Image size 1920x1440 · color fundus image:
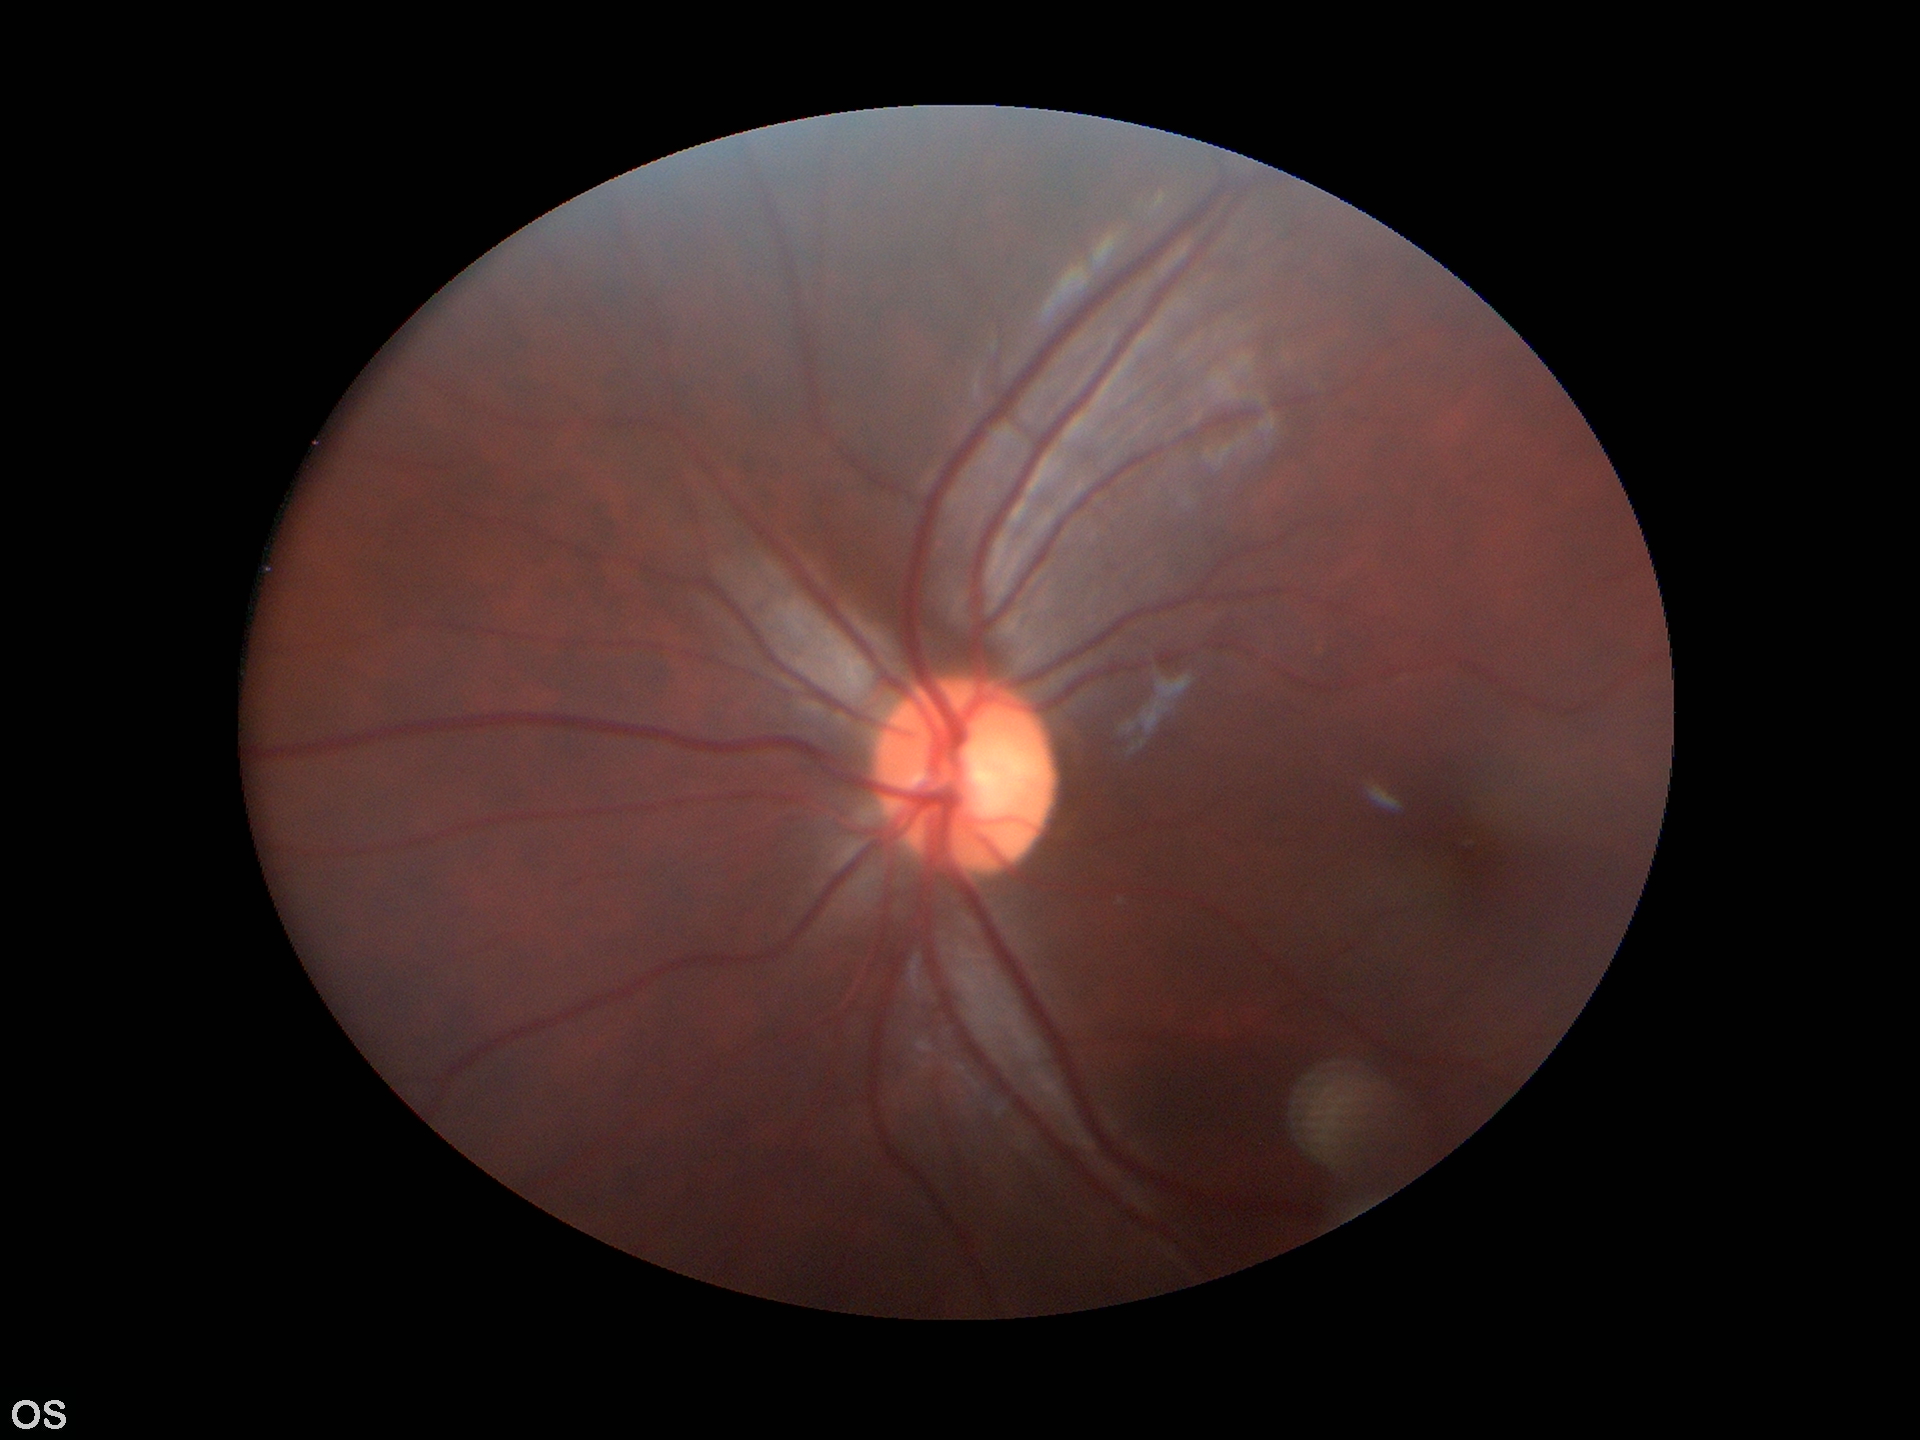 Glaucoma evaluation: no suspicious findings (1 of 5 graders flagged glaucoma suspect). VCDR is 0.51. ACDR of 0.28.